FOV: 45 degrees. 2048x1536 — 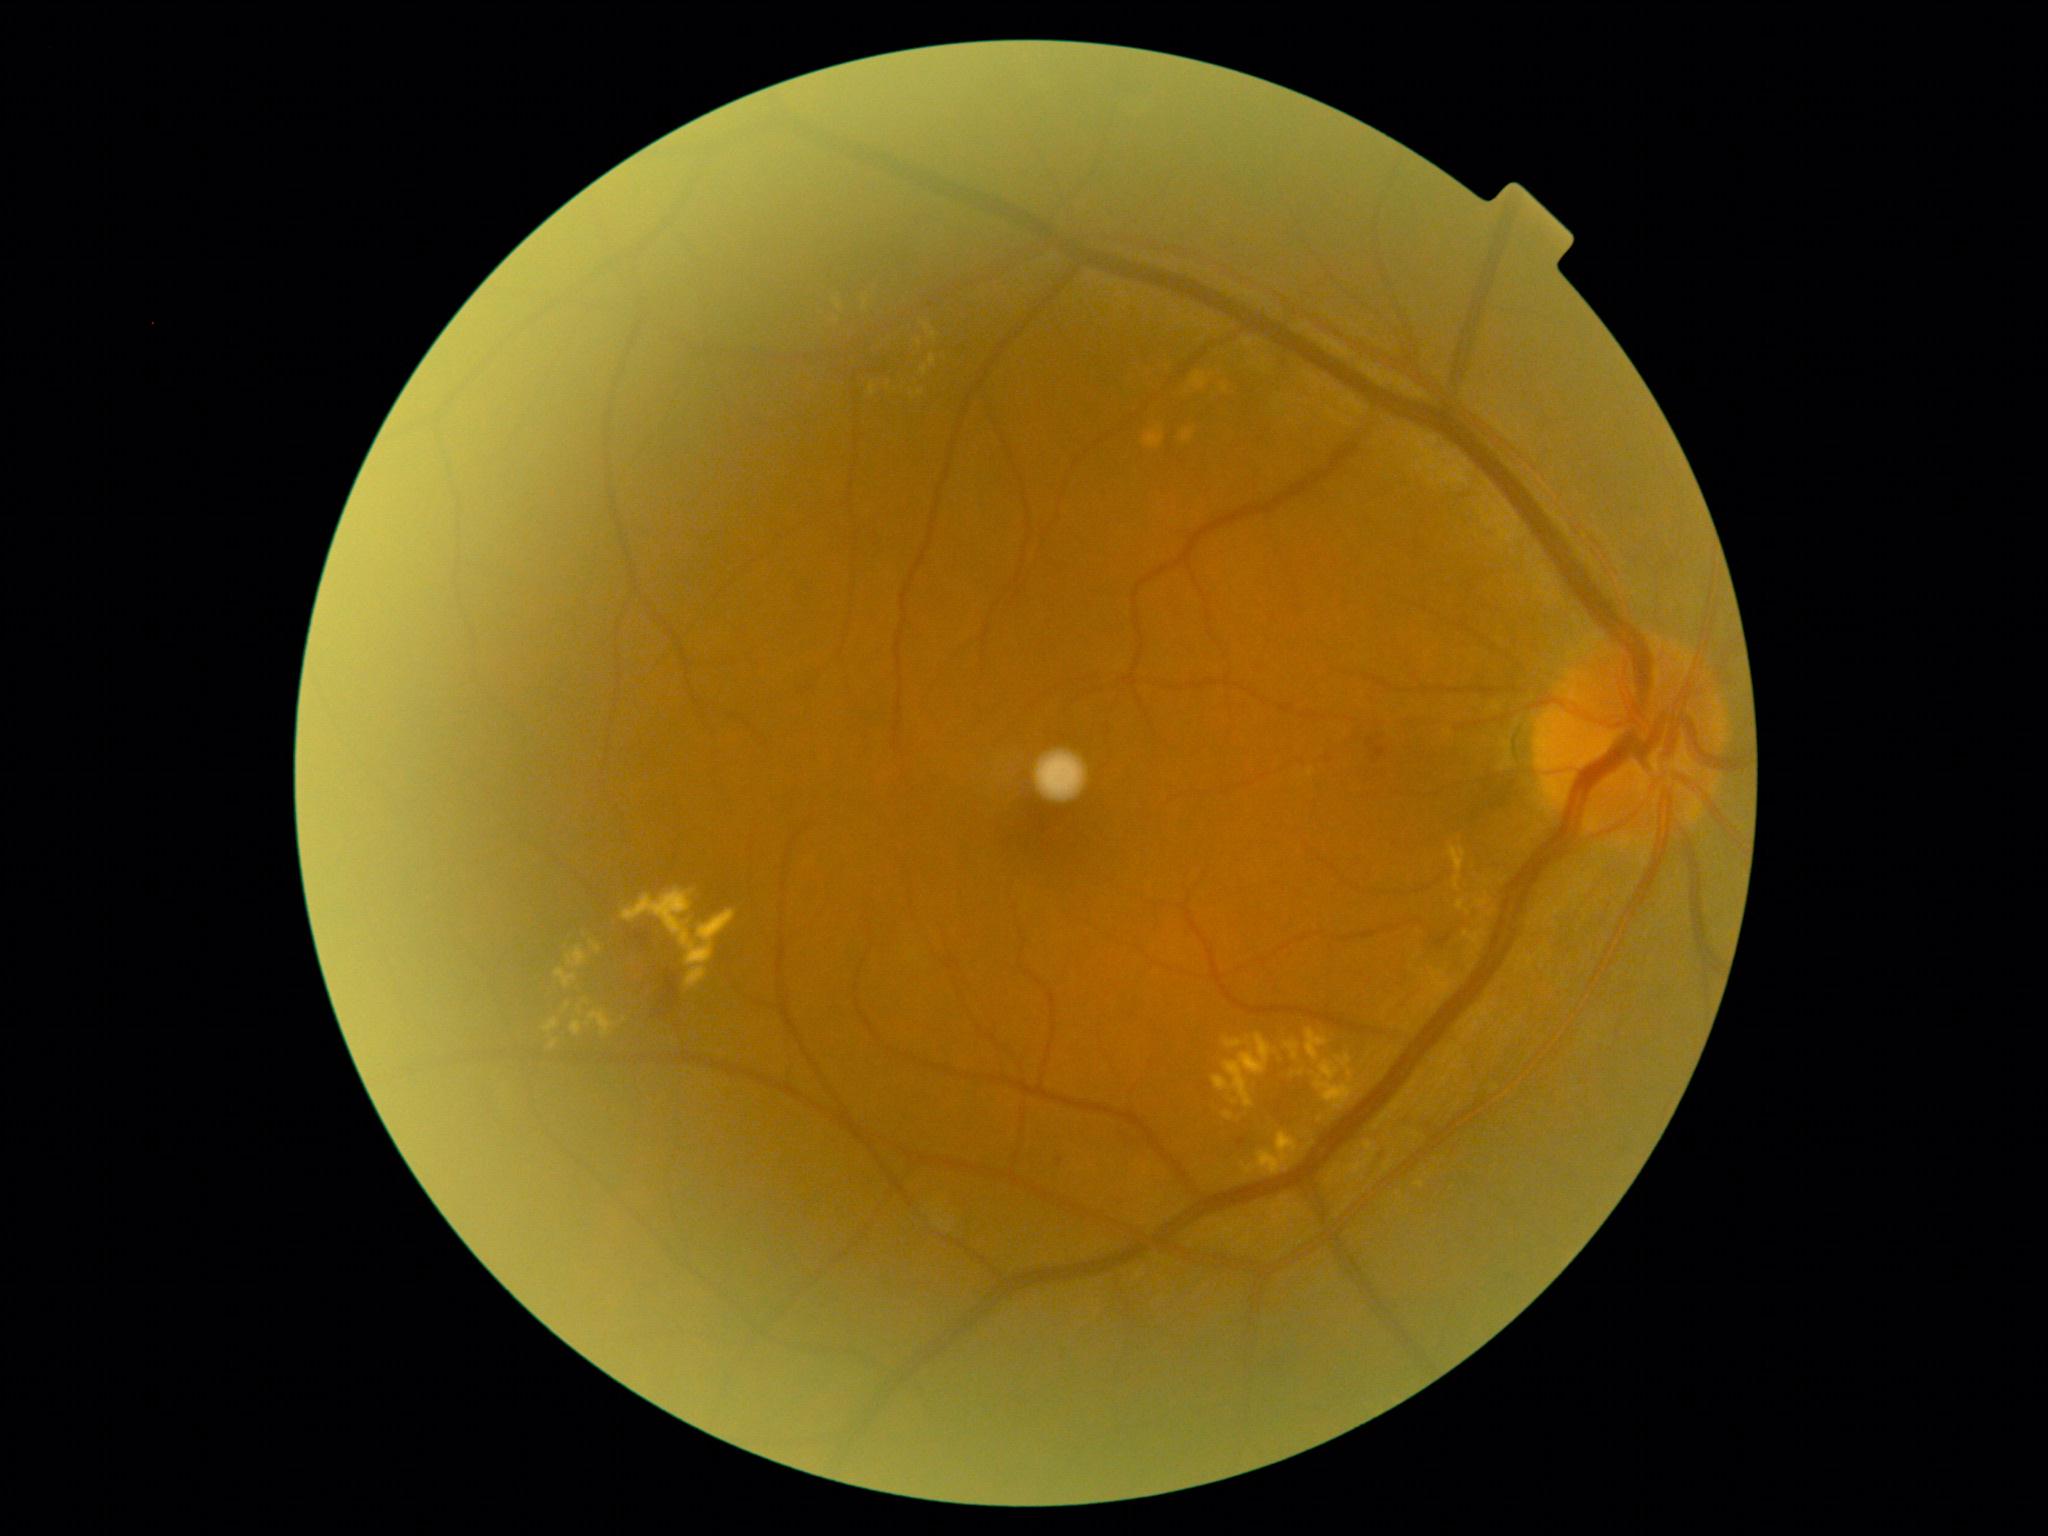

Diabetic retinopathy: grade 2 (moderate NPDR) — more than just microaneurysms but less than severe NPDR
Lesions identified (partial list):
hard exudates (more not shown): [left=929, top=355, right=936, bottom=366] | [left=544, top=1018, right=558, bottom=1033] | [left=833, top=299, right=842, bottom=309] | [left=1212, top=1034, right=1272, bottom=1108] | [left=555, top=968, right=577, bottom=988] | [left=1285, top=1043, right=1299, bottom=1060] | [left=571, top=1021, right=583, bottom=1035] | [left=1315, top=1054, right=1355, bottom=1110] | [left=585, top=1010, right=615, bottom=1037] | [left=564, top=1002, right=571, bottom=1011] | [left=567, top=945, right=588, bottom=967] | [left=578, top=1005, right=583, bottom=1014]
Additional small hard exudates near Point(587, 1001) | Point(1234, 1102) | Point(1321, 1118) | Point(934, 335) | Point(919, 343)